45 degree fundus photograph, nonmydriatic.
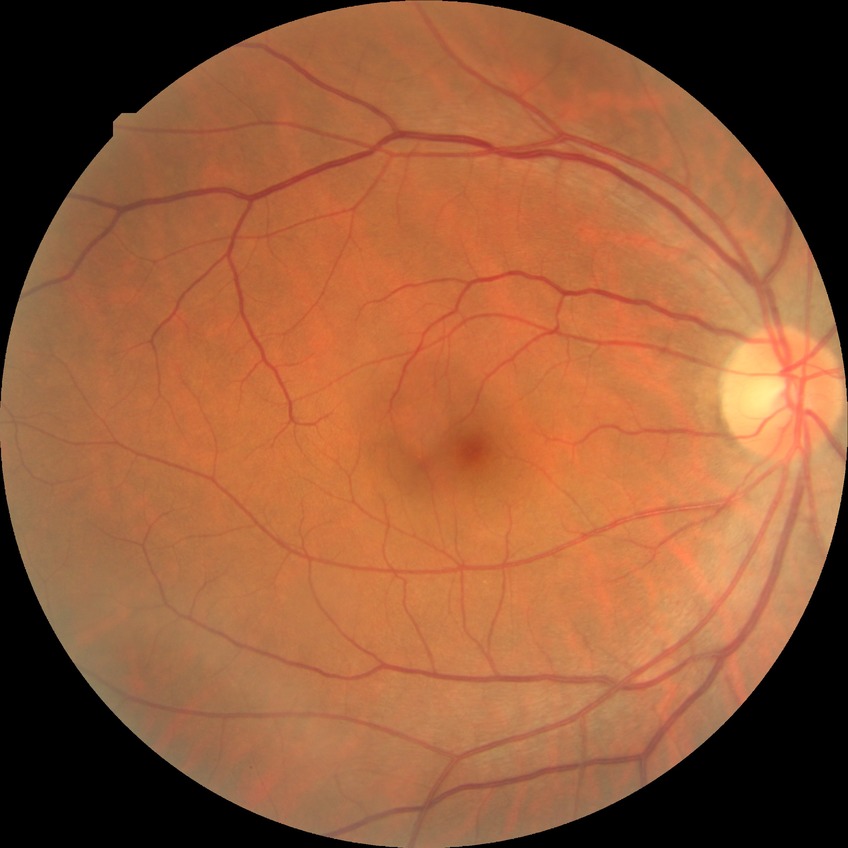

Modified Davis classification: no diabetic retinopathy.